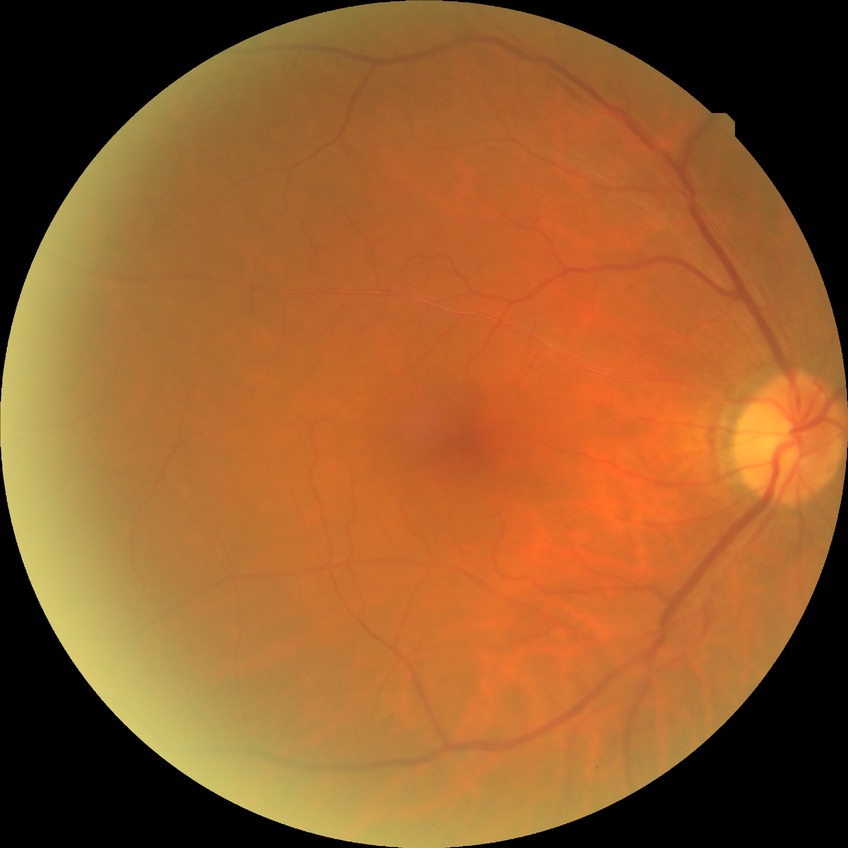 Findings:
– diabetic retinopathy stage — no diabetic retinopathy